Intraocular pressure (IOP) 14 mmHg — 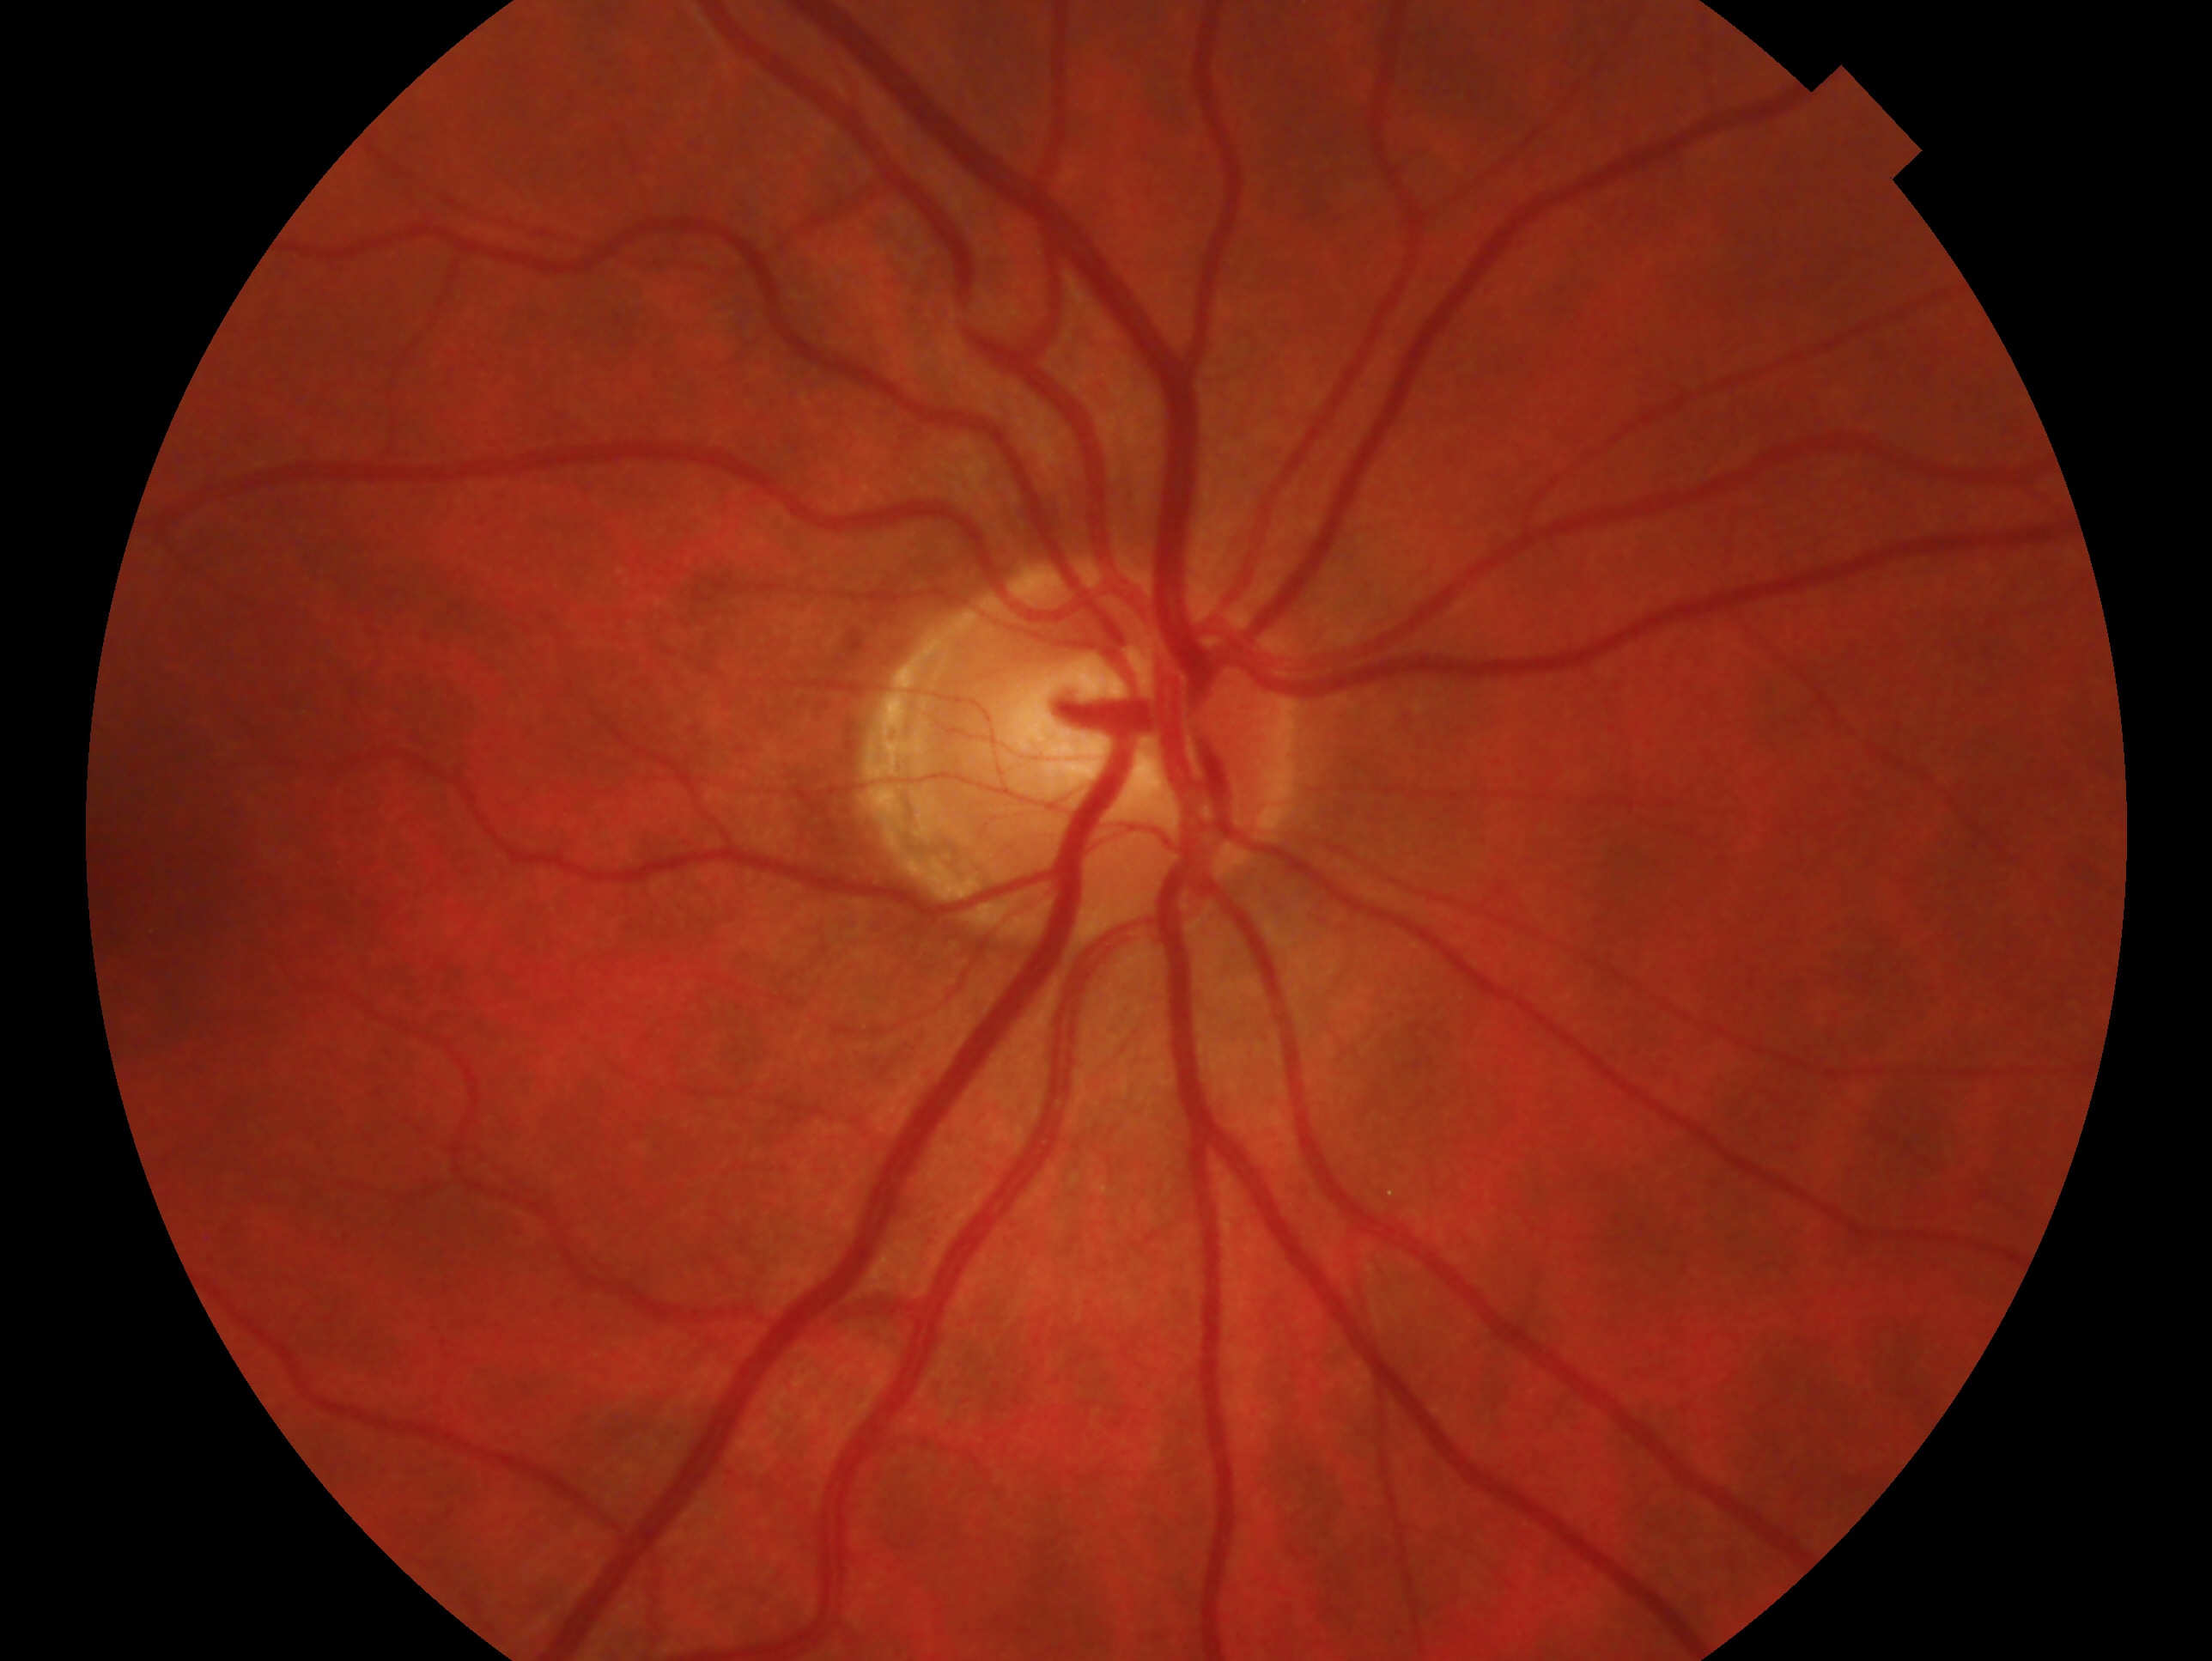 Eye: right eye. Glaucoma status: no evidence of glaucoma.